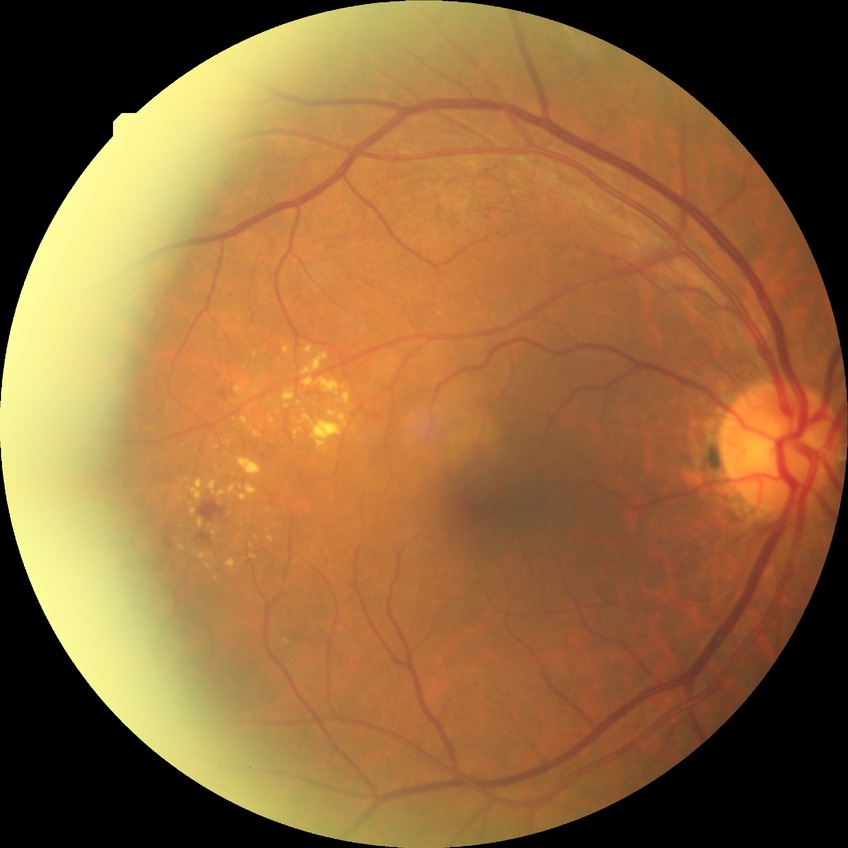

DR grade: SDR.